Wide-field fundus image from infant ROP screening:
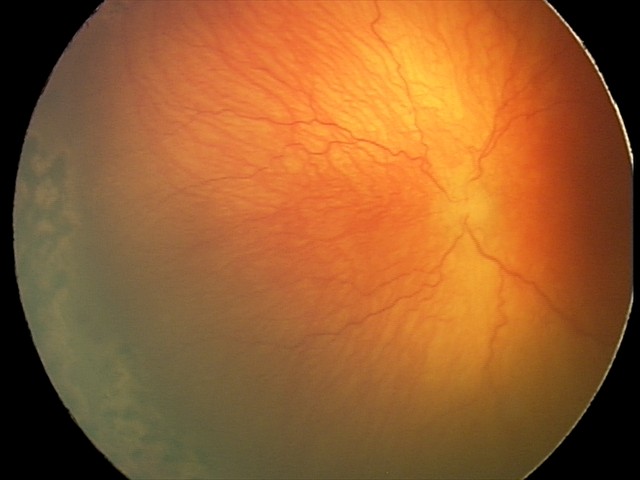

Assessment = aggressive retinopathy of prematurity — rapidly progressive severe ROP with prominent plus disease, often without classic stage progression; plus disease = present — abnormal dilation and tortuosity of the posterior pole retinal vessels.